1725 x 1721 pixels · color fundus photograph: 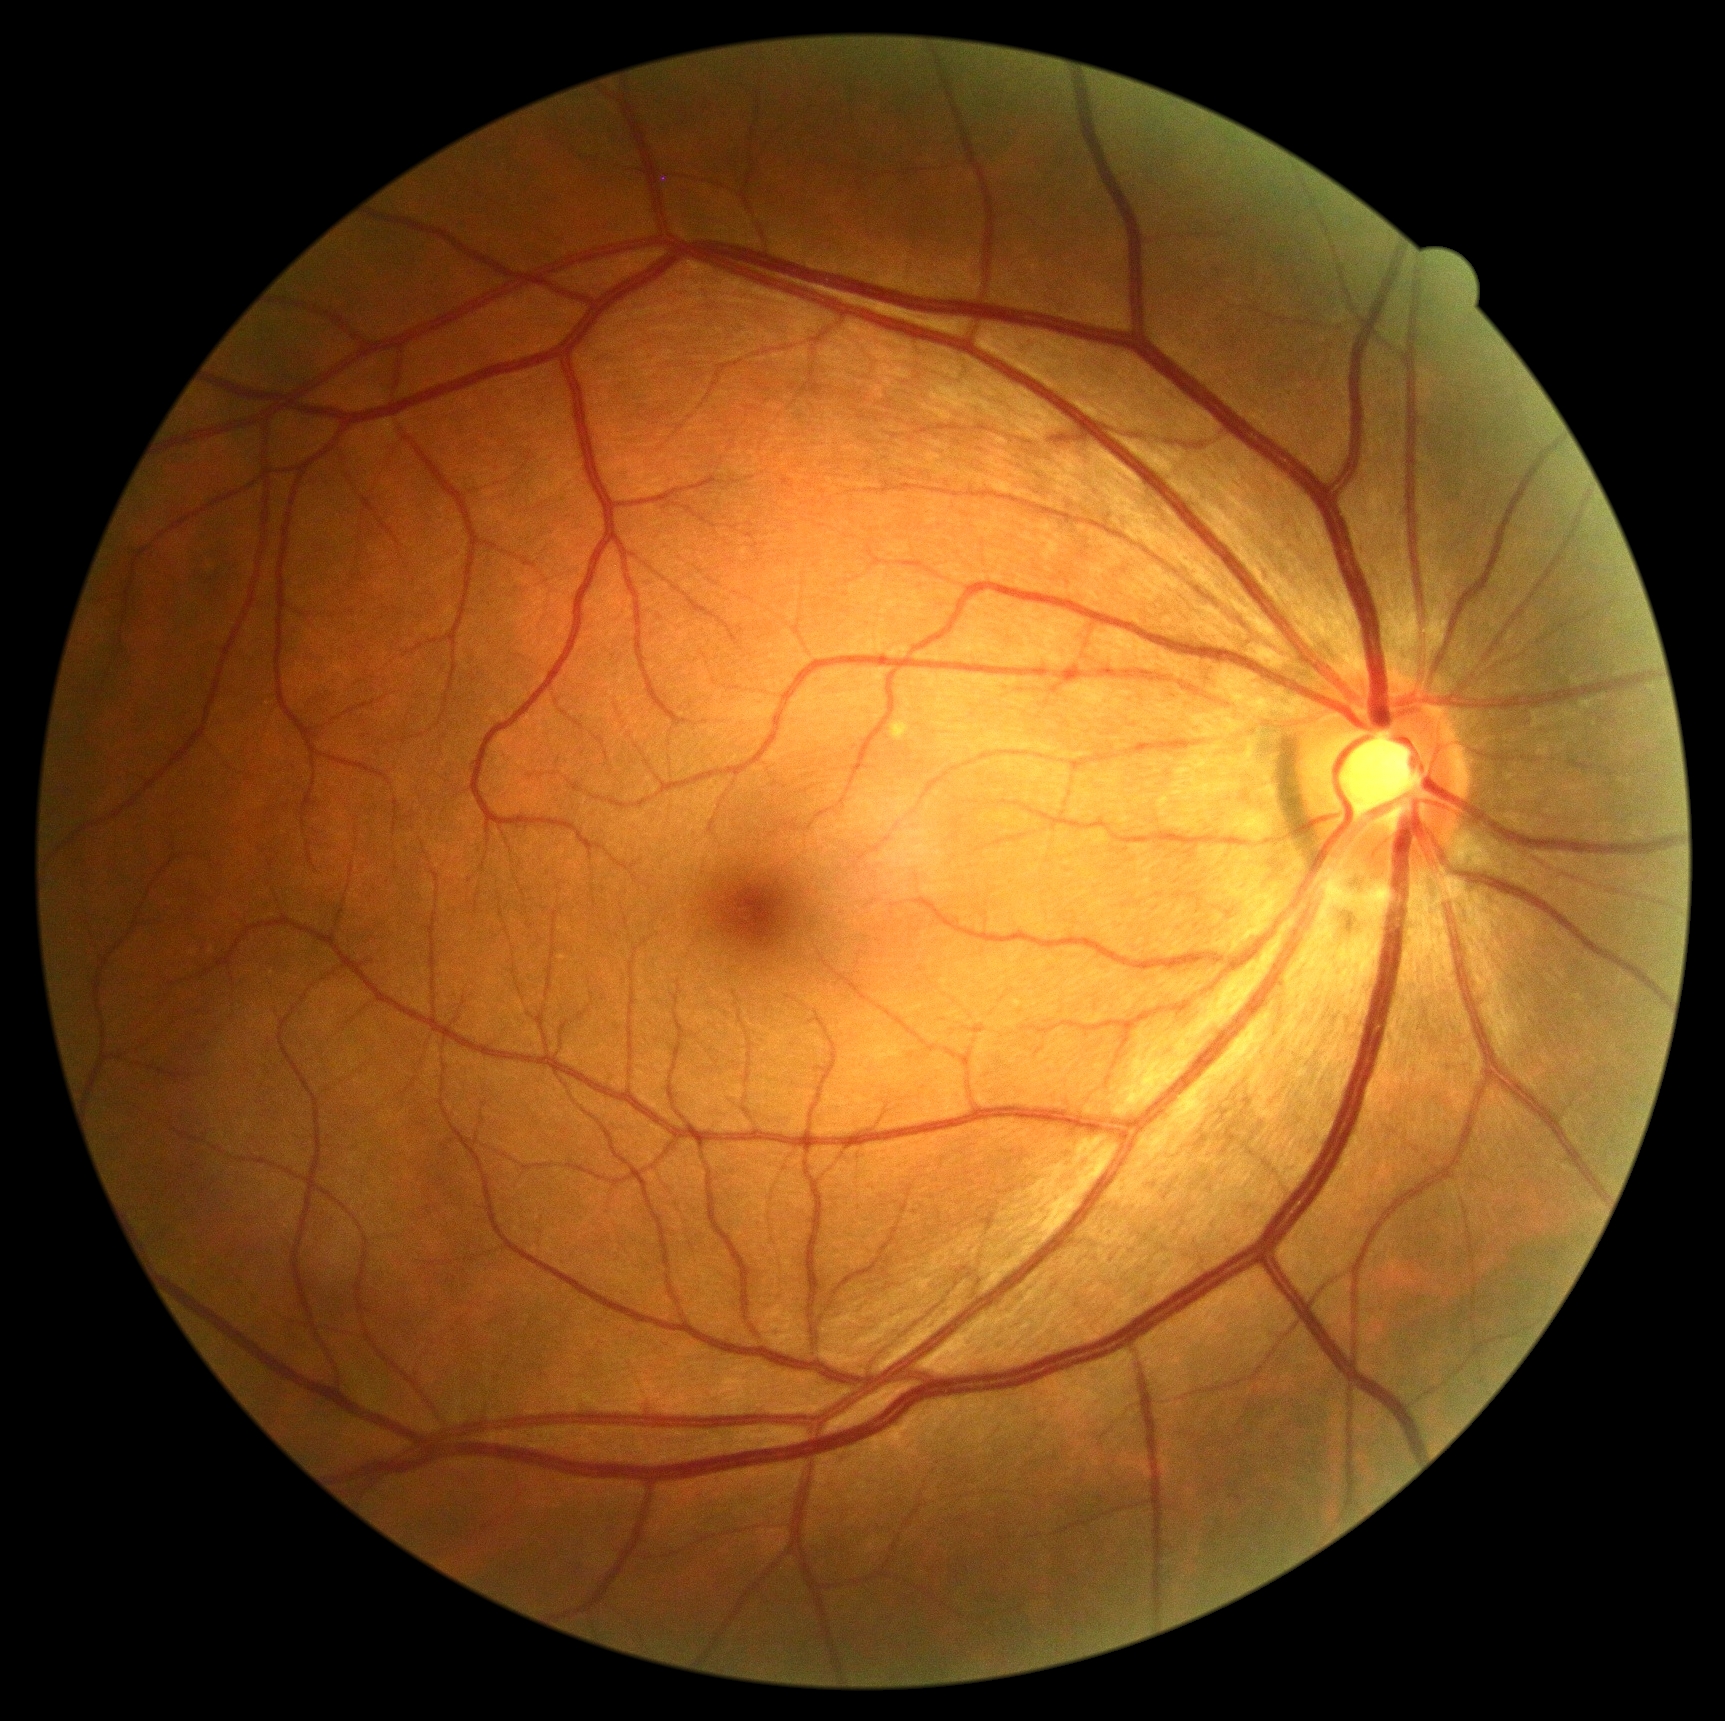
Retinopathy is no apparent retinopathy (grade 0).